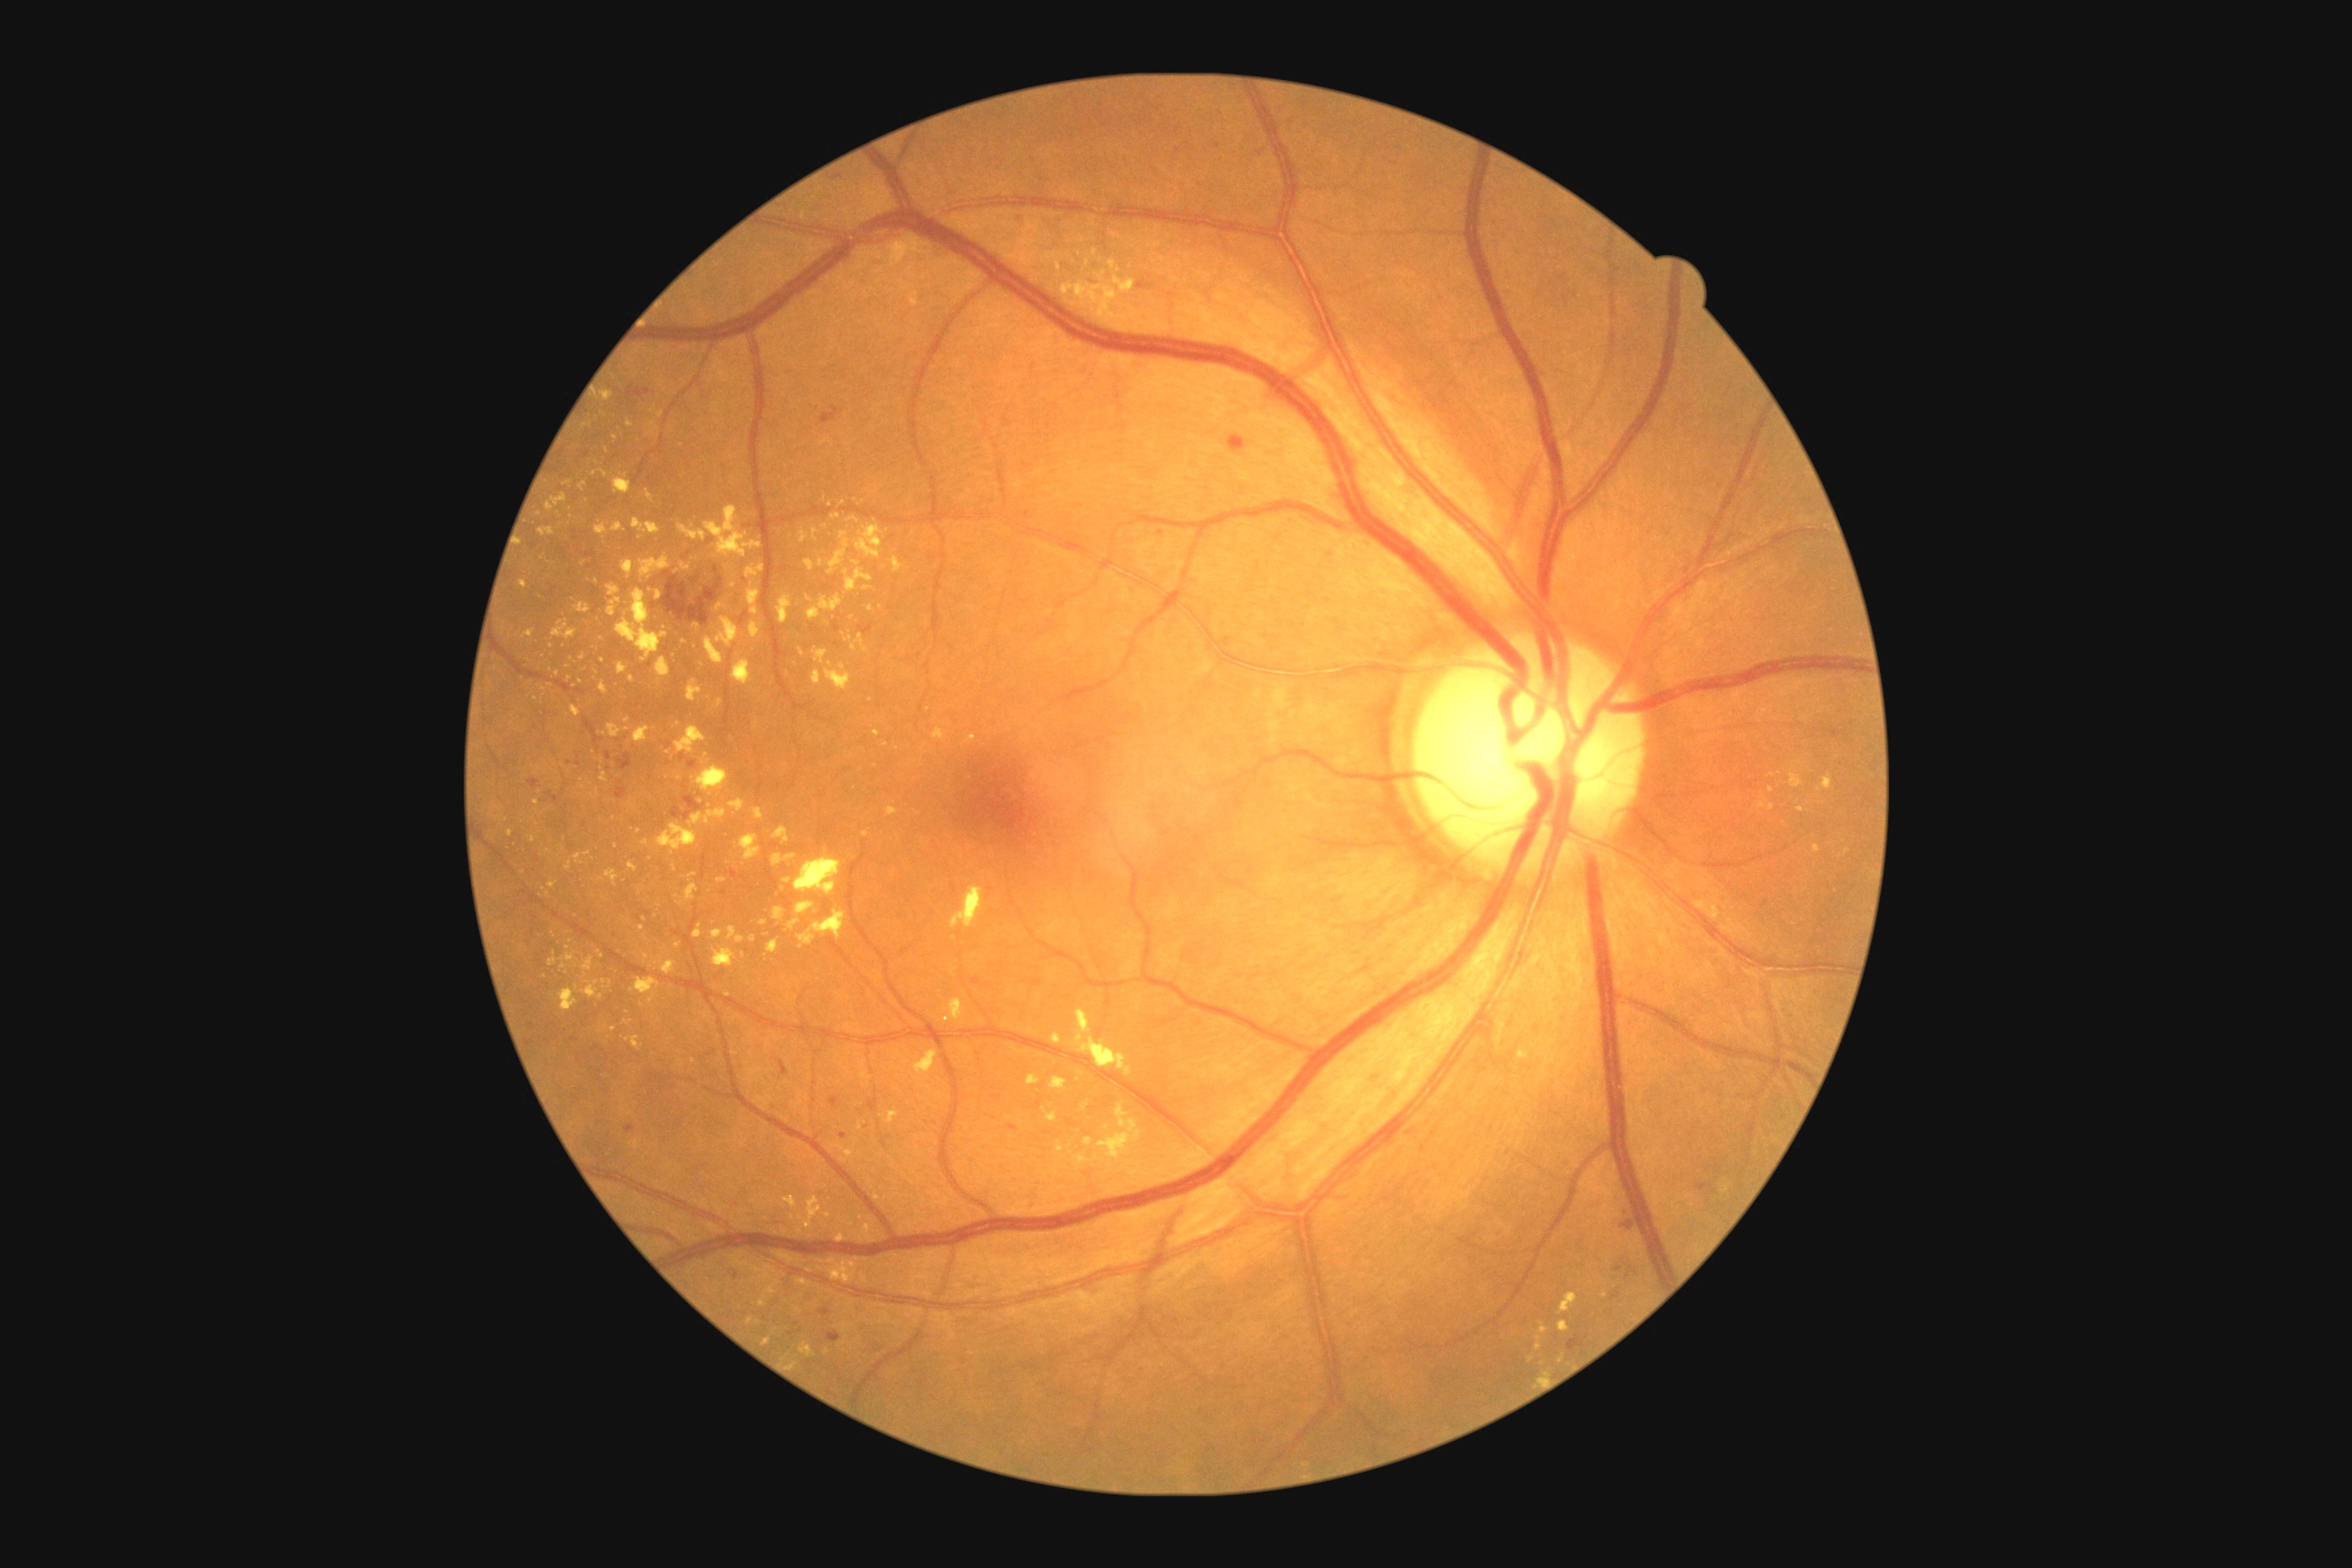

DR severity is grade 2 (moderate NPDR)
Selected lesions:
EXs (more not shown): box(578, 482, 587, 493); box(774, 908, 785, 921); box(732, 660, 752, 687); box(1814, 845, 1821, 854); box(932, 729, 946, 741); box(507, 830, 513, 838); box(565, 861, 573, 872); box(796, 903, 816, 916); box(839, 663, 847, 671); box(828, 531, 850, 576); box(727, 926, 745, 945)
EXs (small, approximate centers) near pt(1562, 1361); pt(1848, 852); pt(540, 514); pt(597, 581); pt(871, 608); pt(830, 505); pt(645, 919); pt(628, 720)